45° field of view · color fundus image
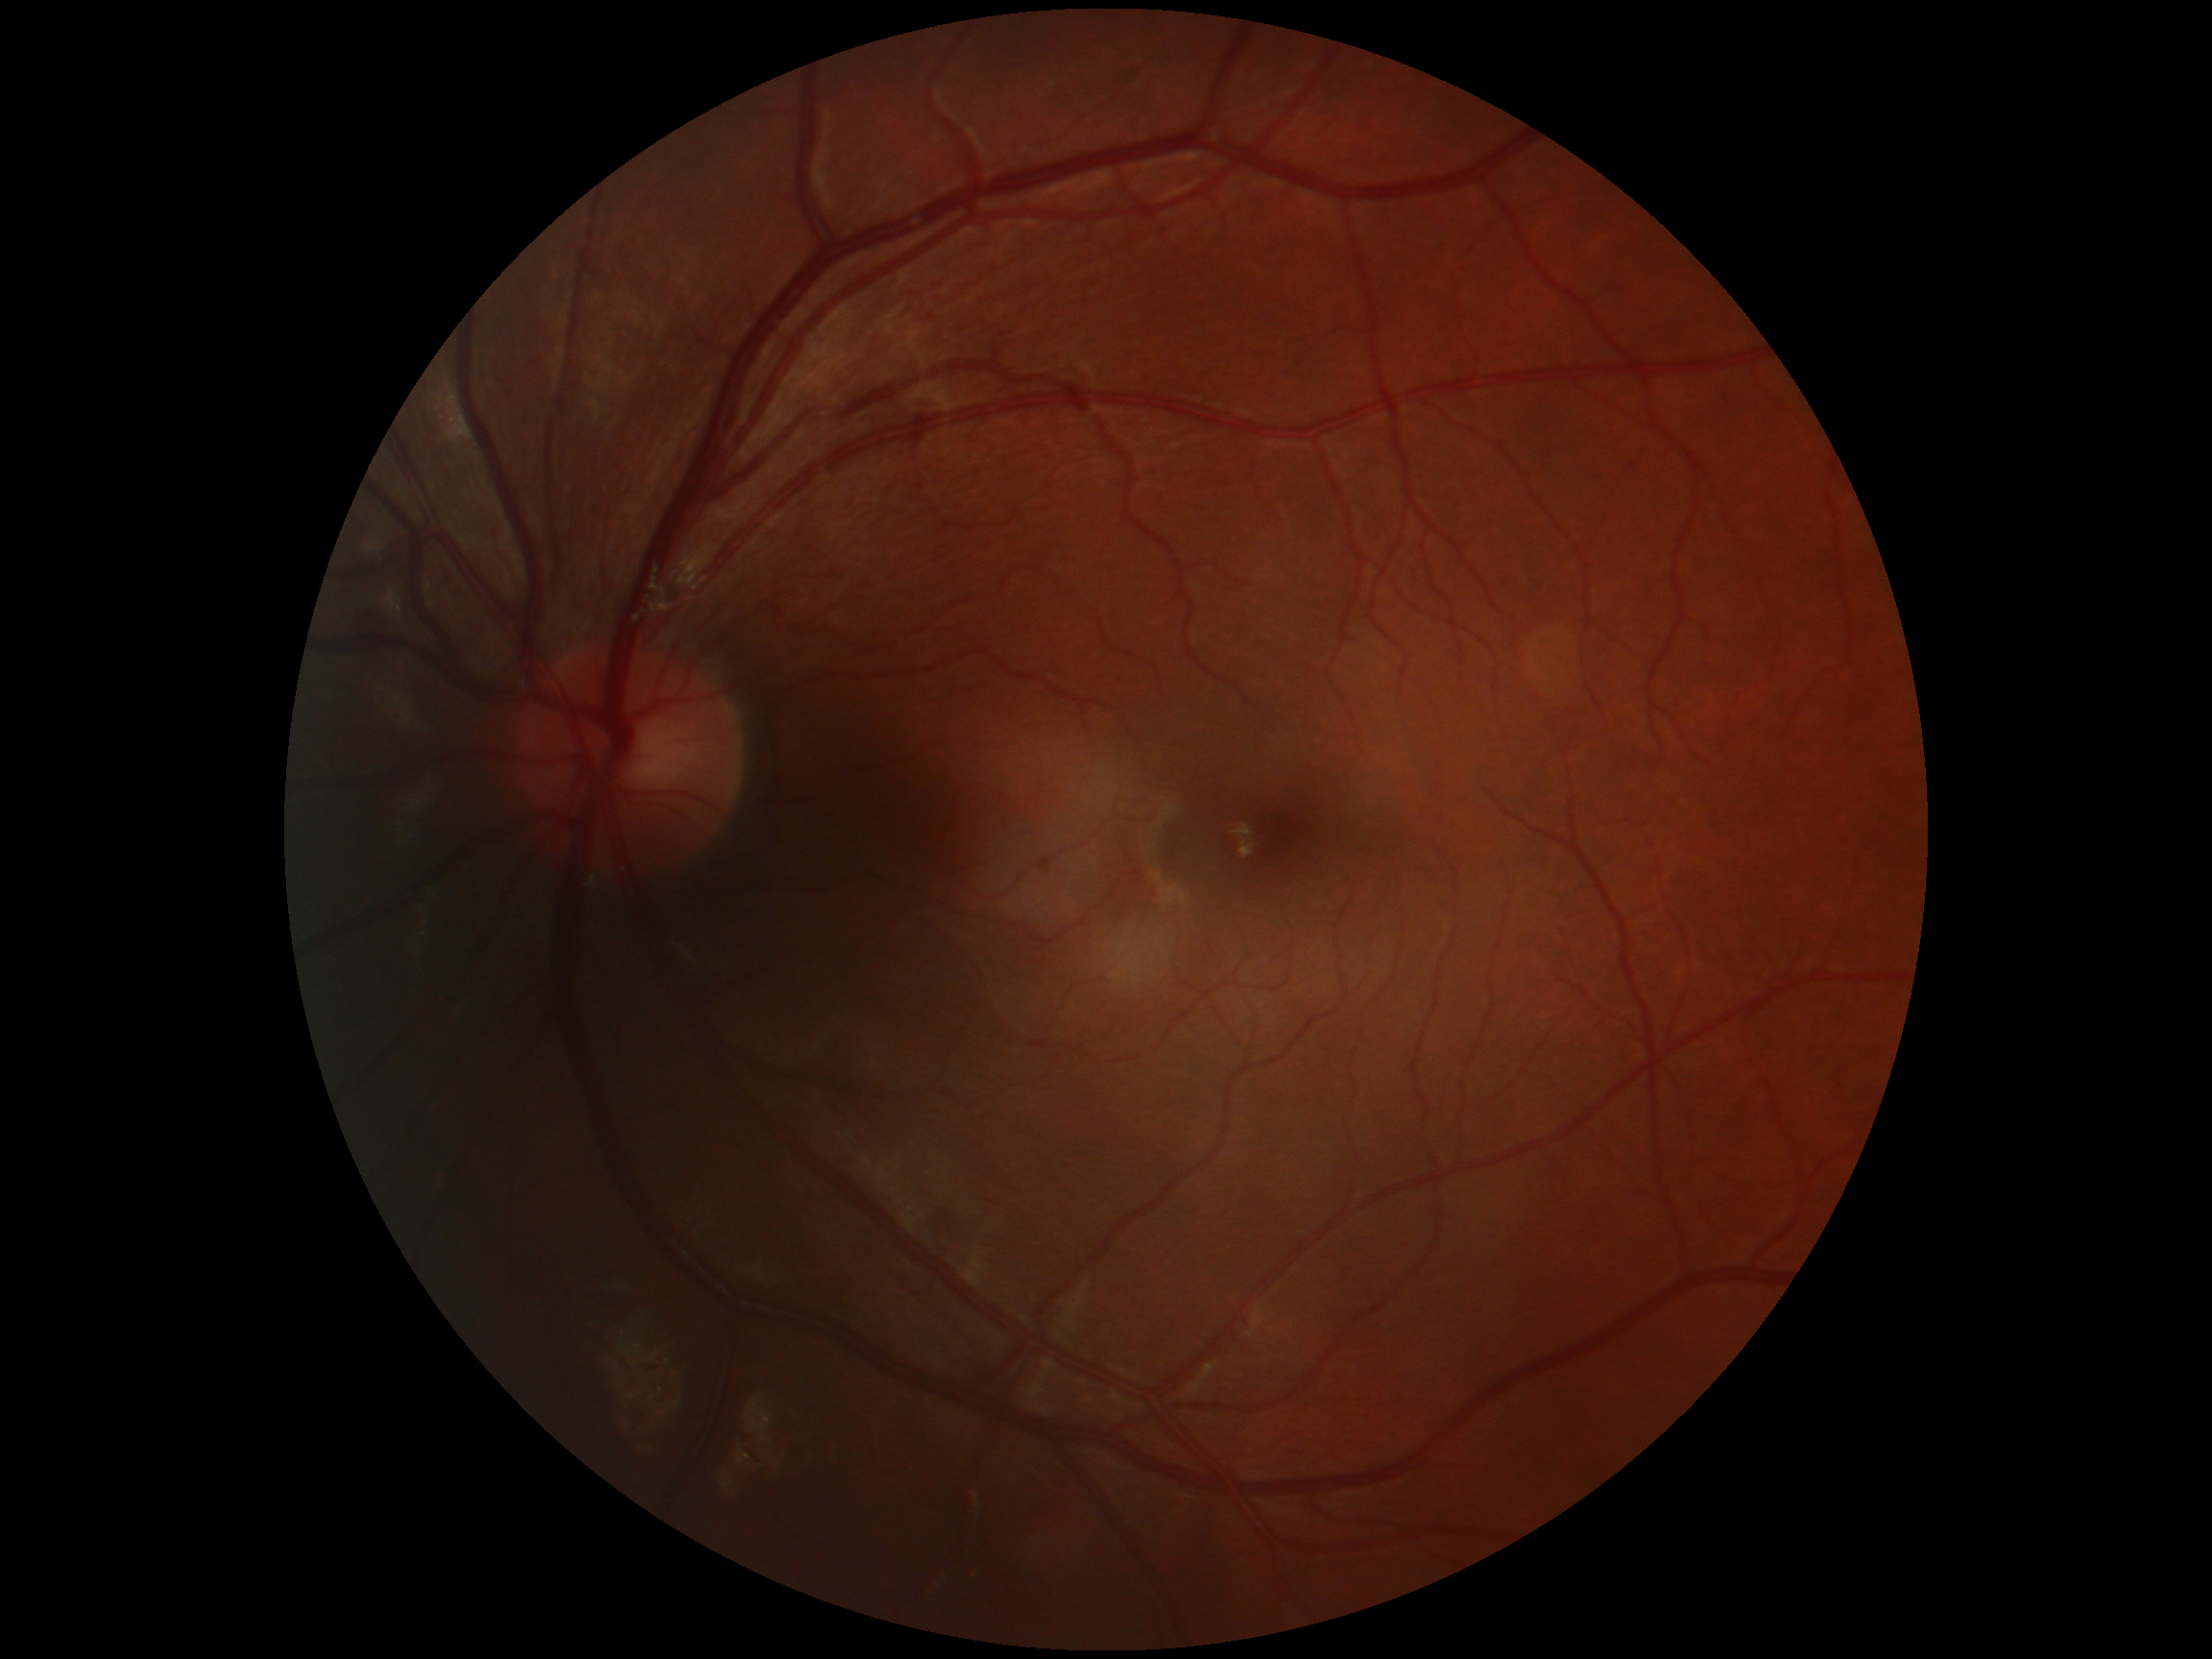   dr_grade: no apparent diabetic retinopathy (grade 0)